45-degree field of view.
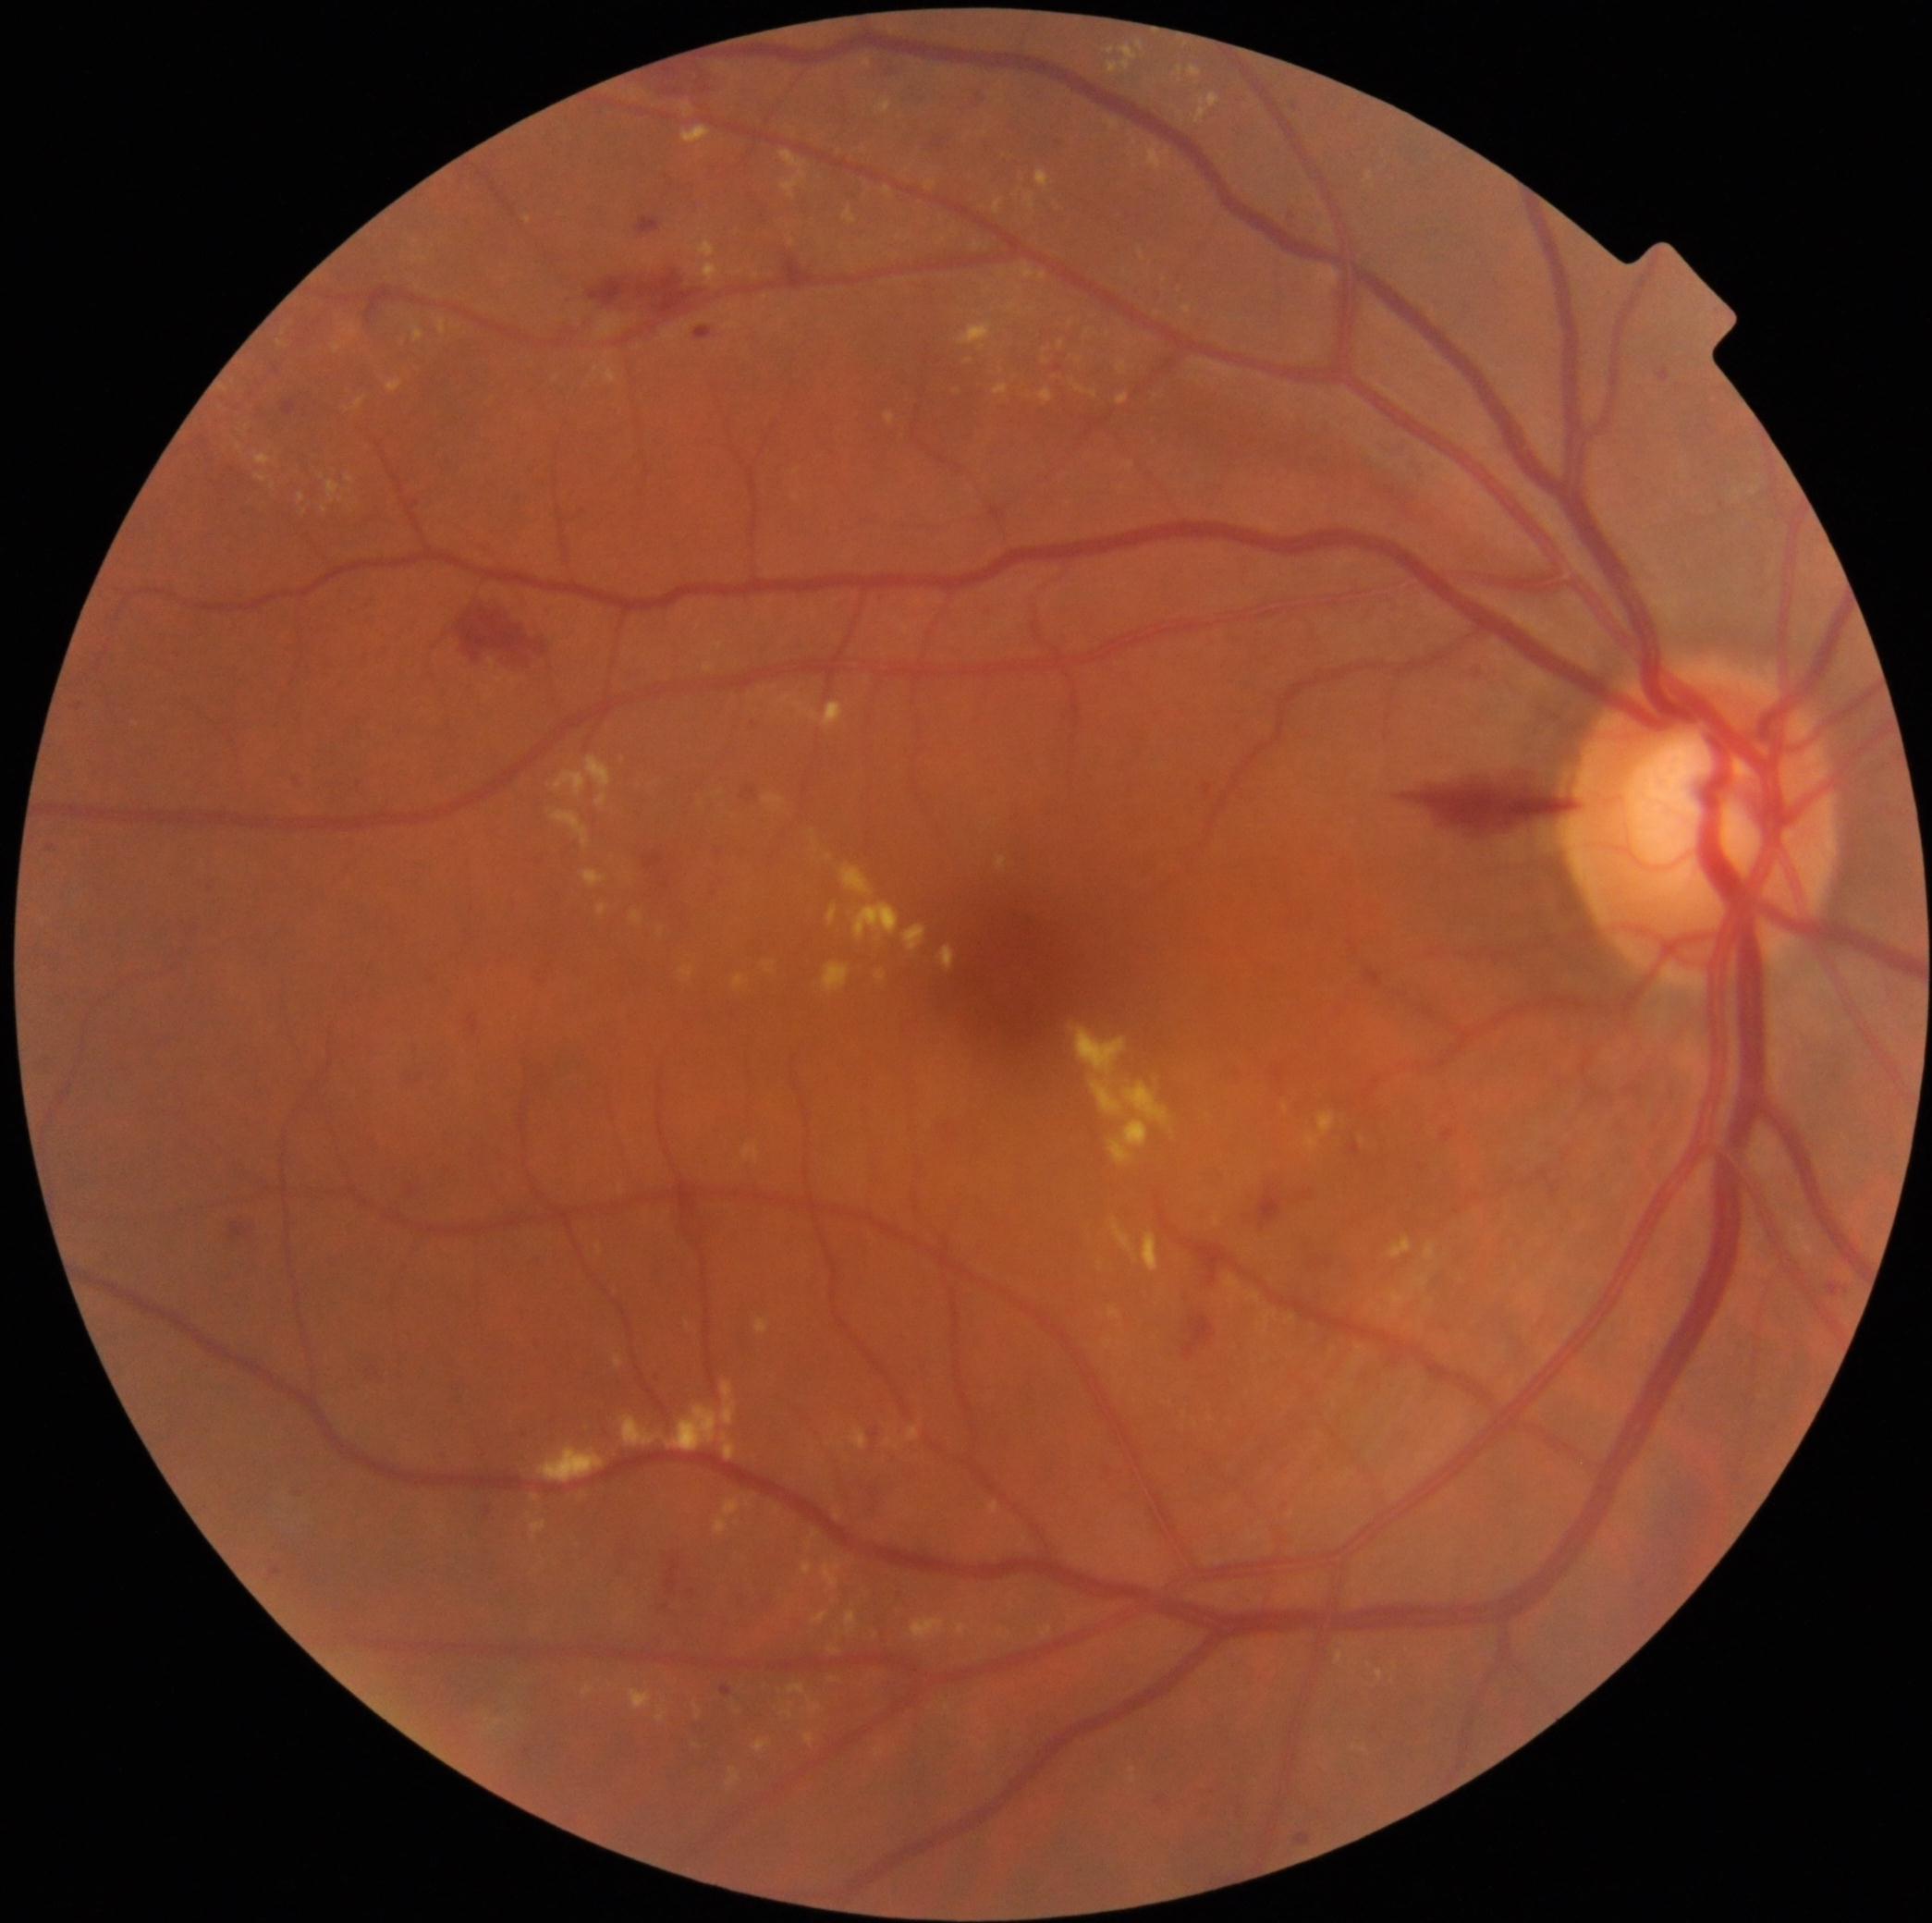

Diabetic retinopathy (DR) is grade 2
A subset of detected lesions:
hard exudates (EXs) (more not shown): 1182 306 1192 315 | 939 946 956 971 | 855 903 899 942 | 344 323 359 337 | 788 1684 821 1715 | 994 385 1009 396 | 703 663 715 673 | 821 1562 842 1590 | 680 966 696 978 | 1189 67 1202 78 | 596 1243 602 1255 | 1138 43 1143 52 | 1036 171 1052 190
Small EXs near Point(1164, 281) | Point(1362, 1141) | Point(810, 1544) | Point(1428, 1302) | Point(305, 513) | Point(1080, 361)